Camera: NIDEK AFC-230; modified Davis classification.
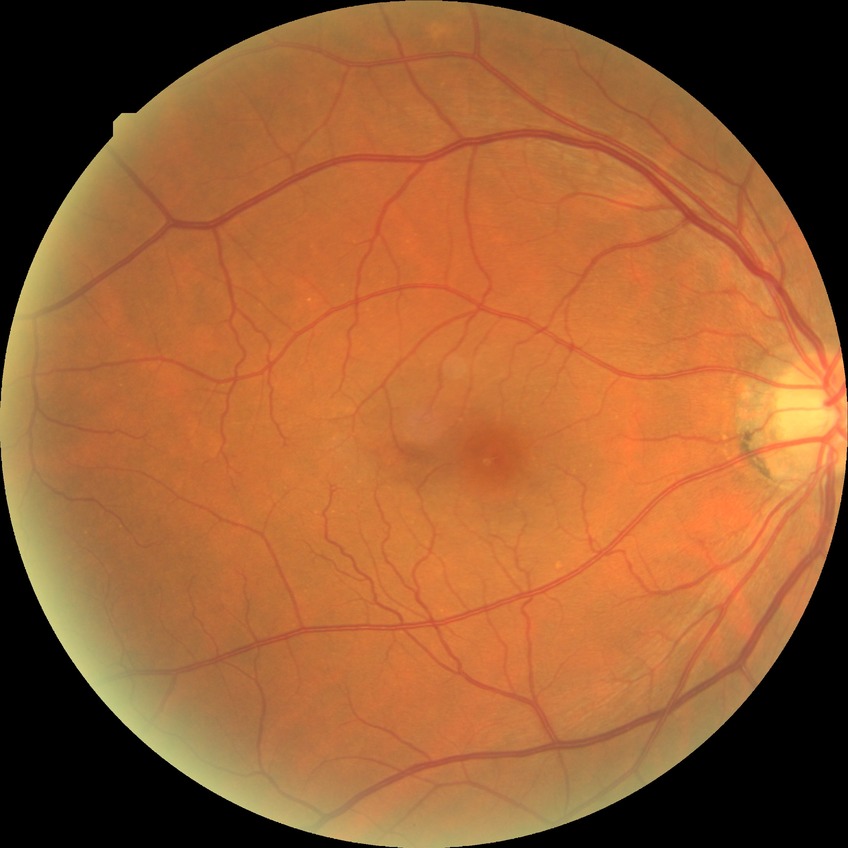

Diabetic retinopathy (DR): NDR (no diabetic retinopathy).